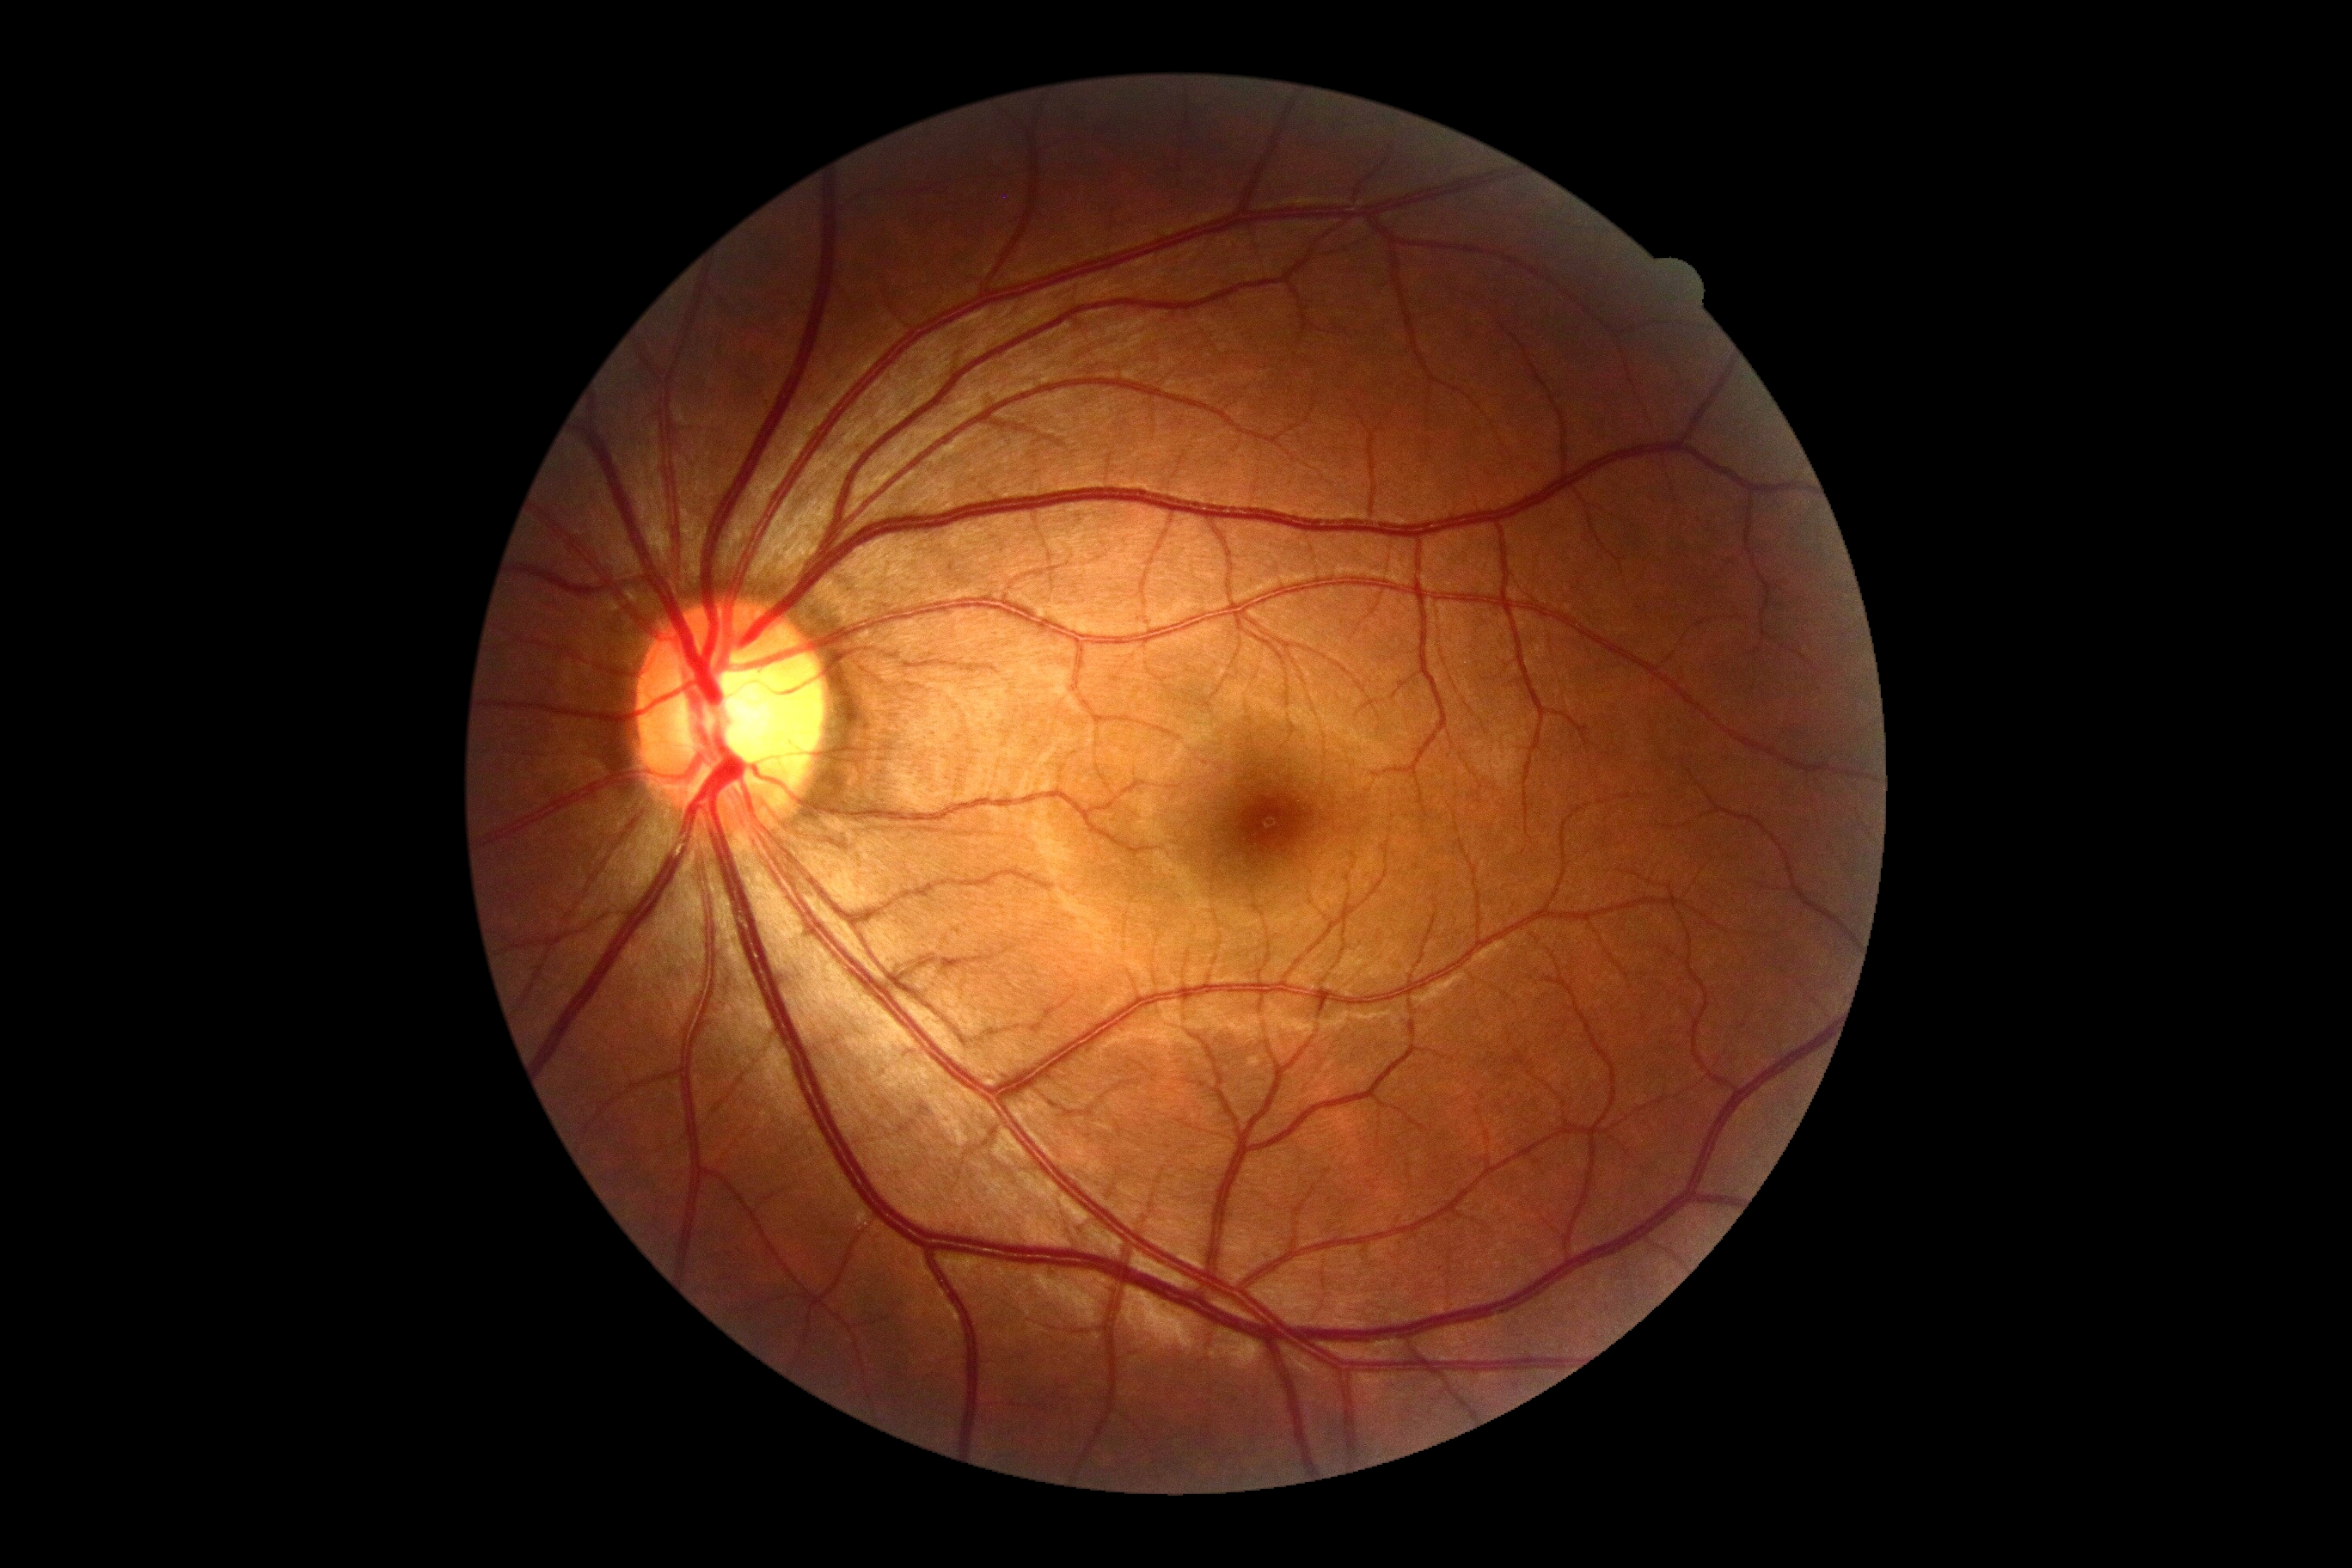

Diabetic retinopathy severity is no apparent diabetic retinopathy (grade 0).